Pediatric wide-field fundus photograph · Clarity RetCam 3, 130° FOV: 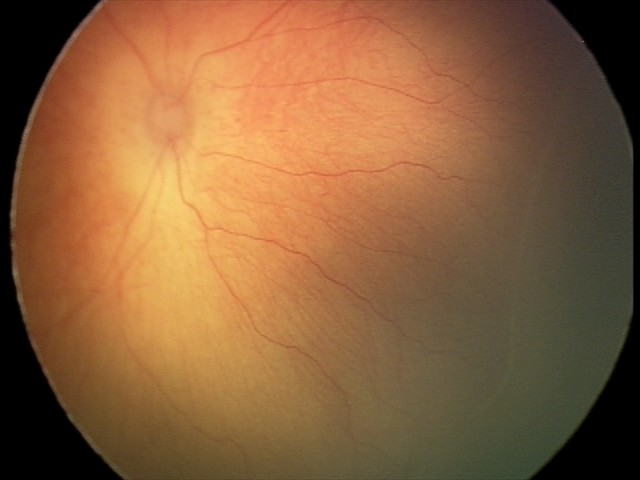

Retinopathy of prematurity: stage 2 — ridge with height and width at the demarcation line, plus form: absent.